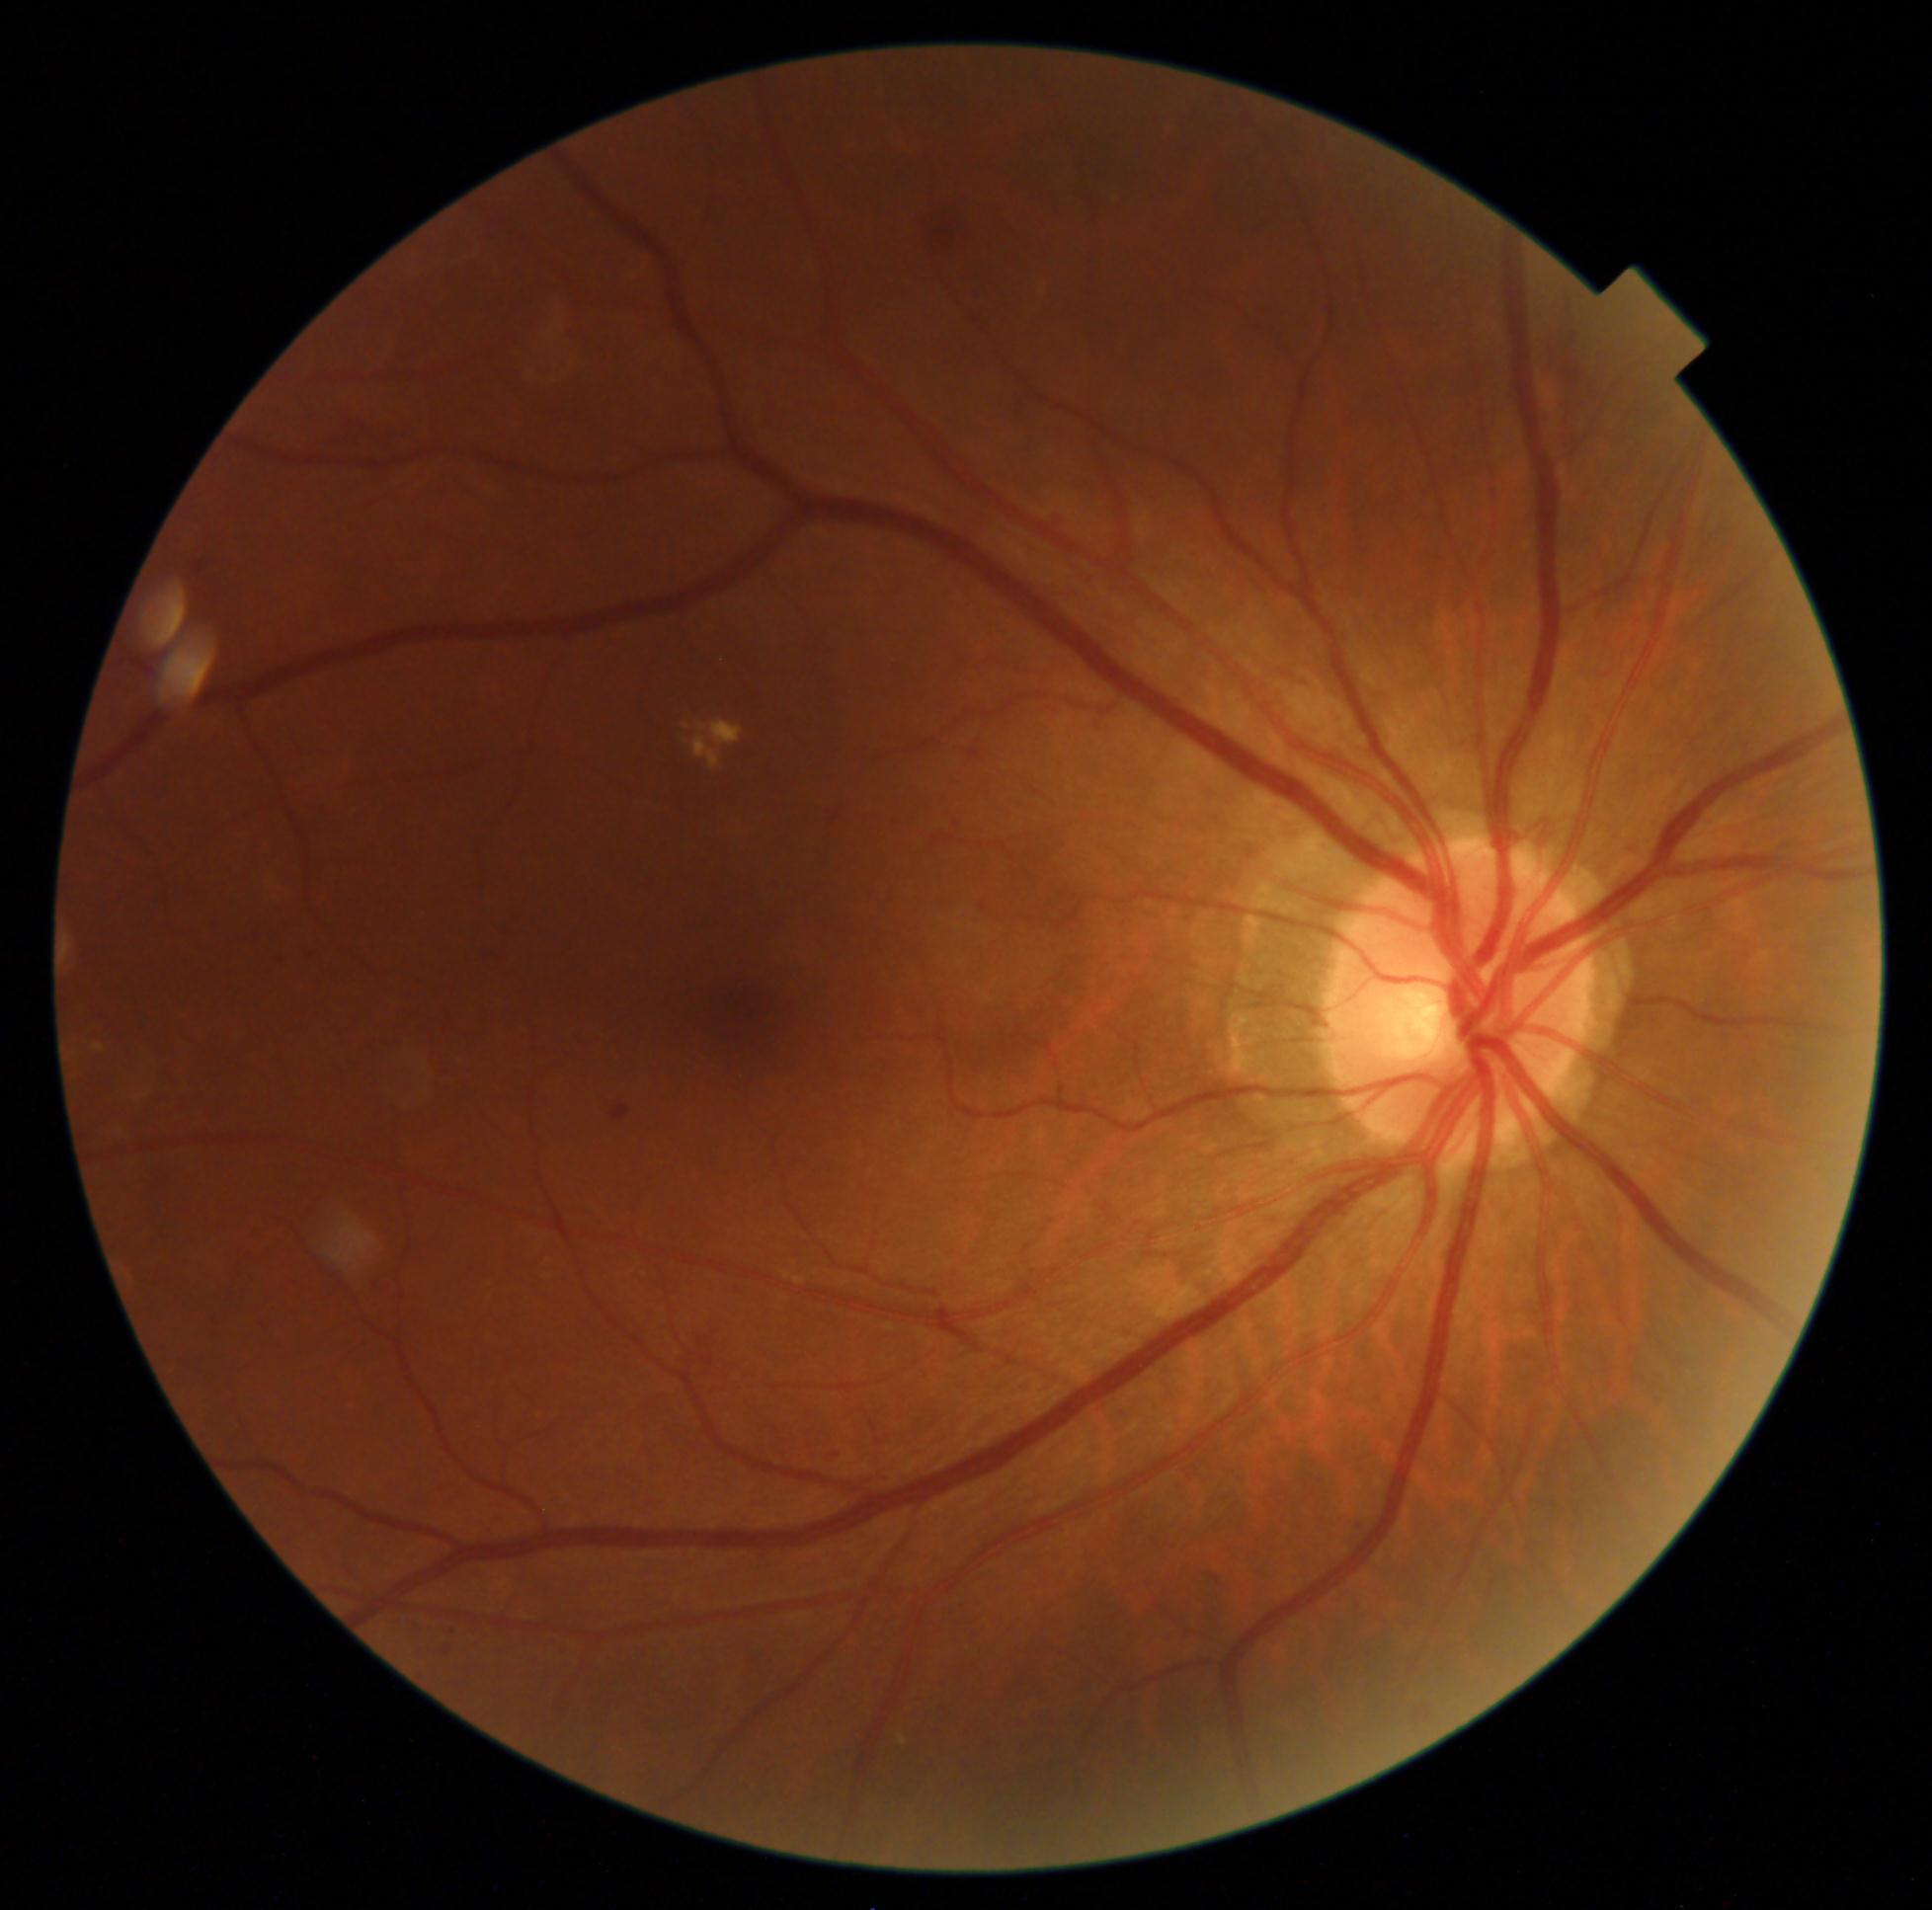
Findings:
• DR stage — moderate non-proliferative diabetic retinopathy (grade 2)